Image size 848x848 · 45° FOV · modified Davis grading
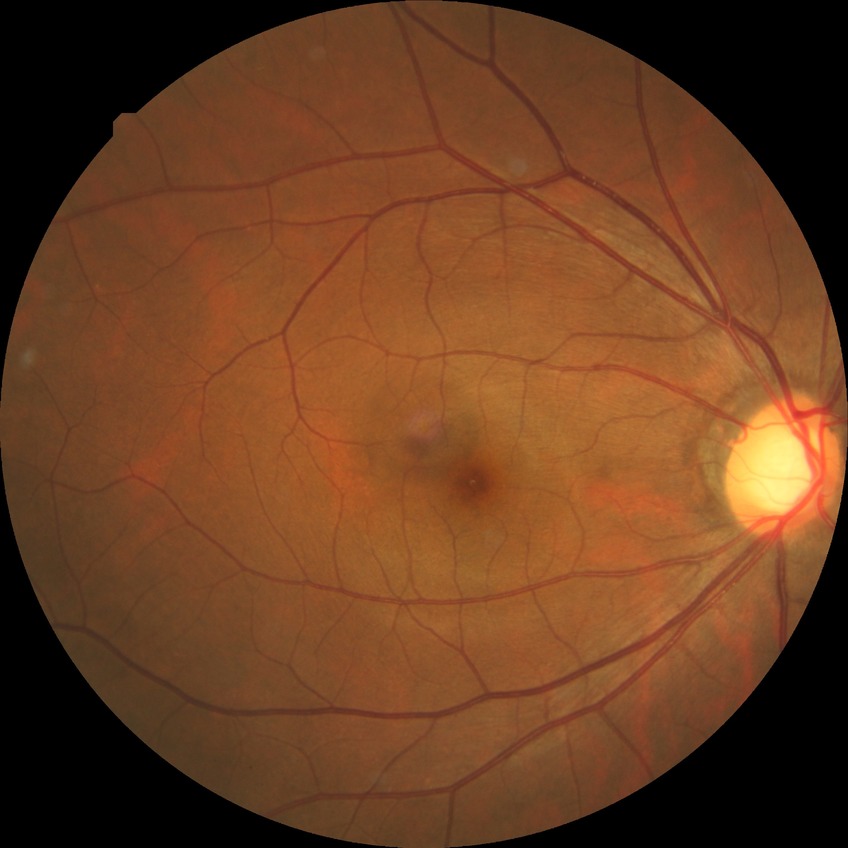 Diabetic retinopathy (DR): NDR (no diabetic retinopathy).